45 degree fundus photograph; nonmydriatic; CFP; DR severity per modified Davis staging; NIDEK AFC-230; 848 by 848 pixels — 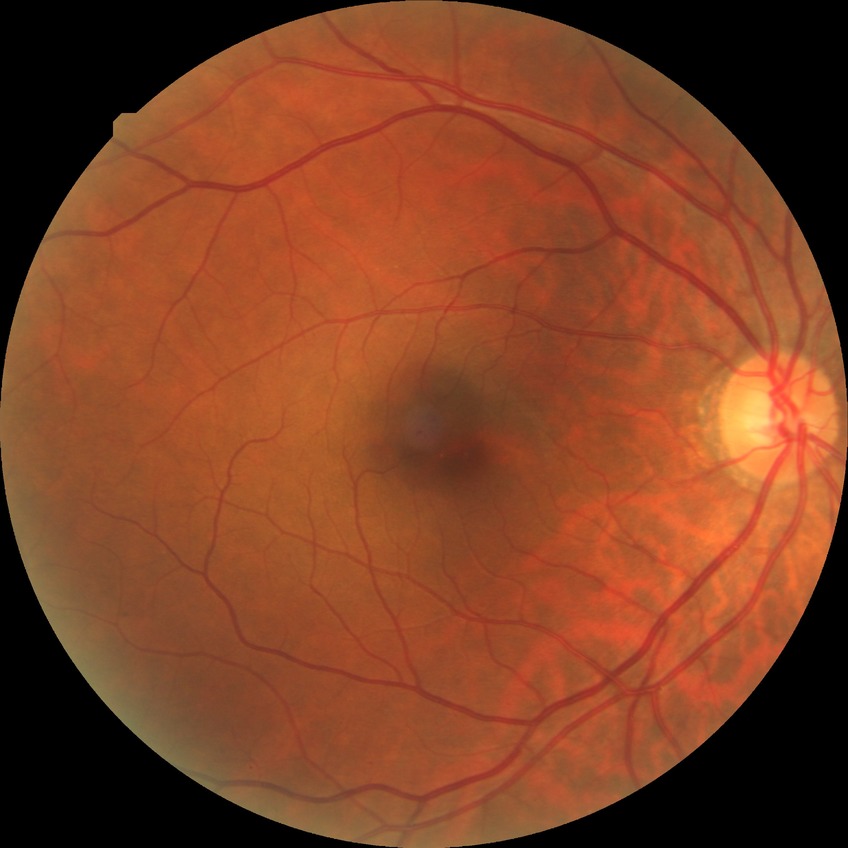   davis_grade: simple diabetic retinopathy (SDR)